2352x1568 · 45° field of view · color fundus photograph:
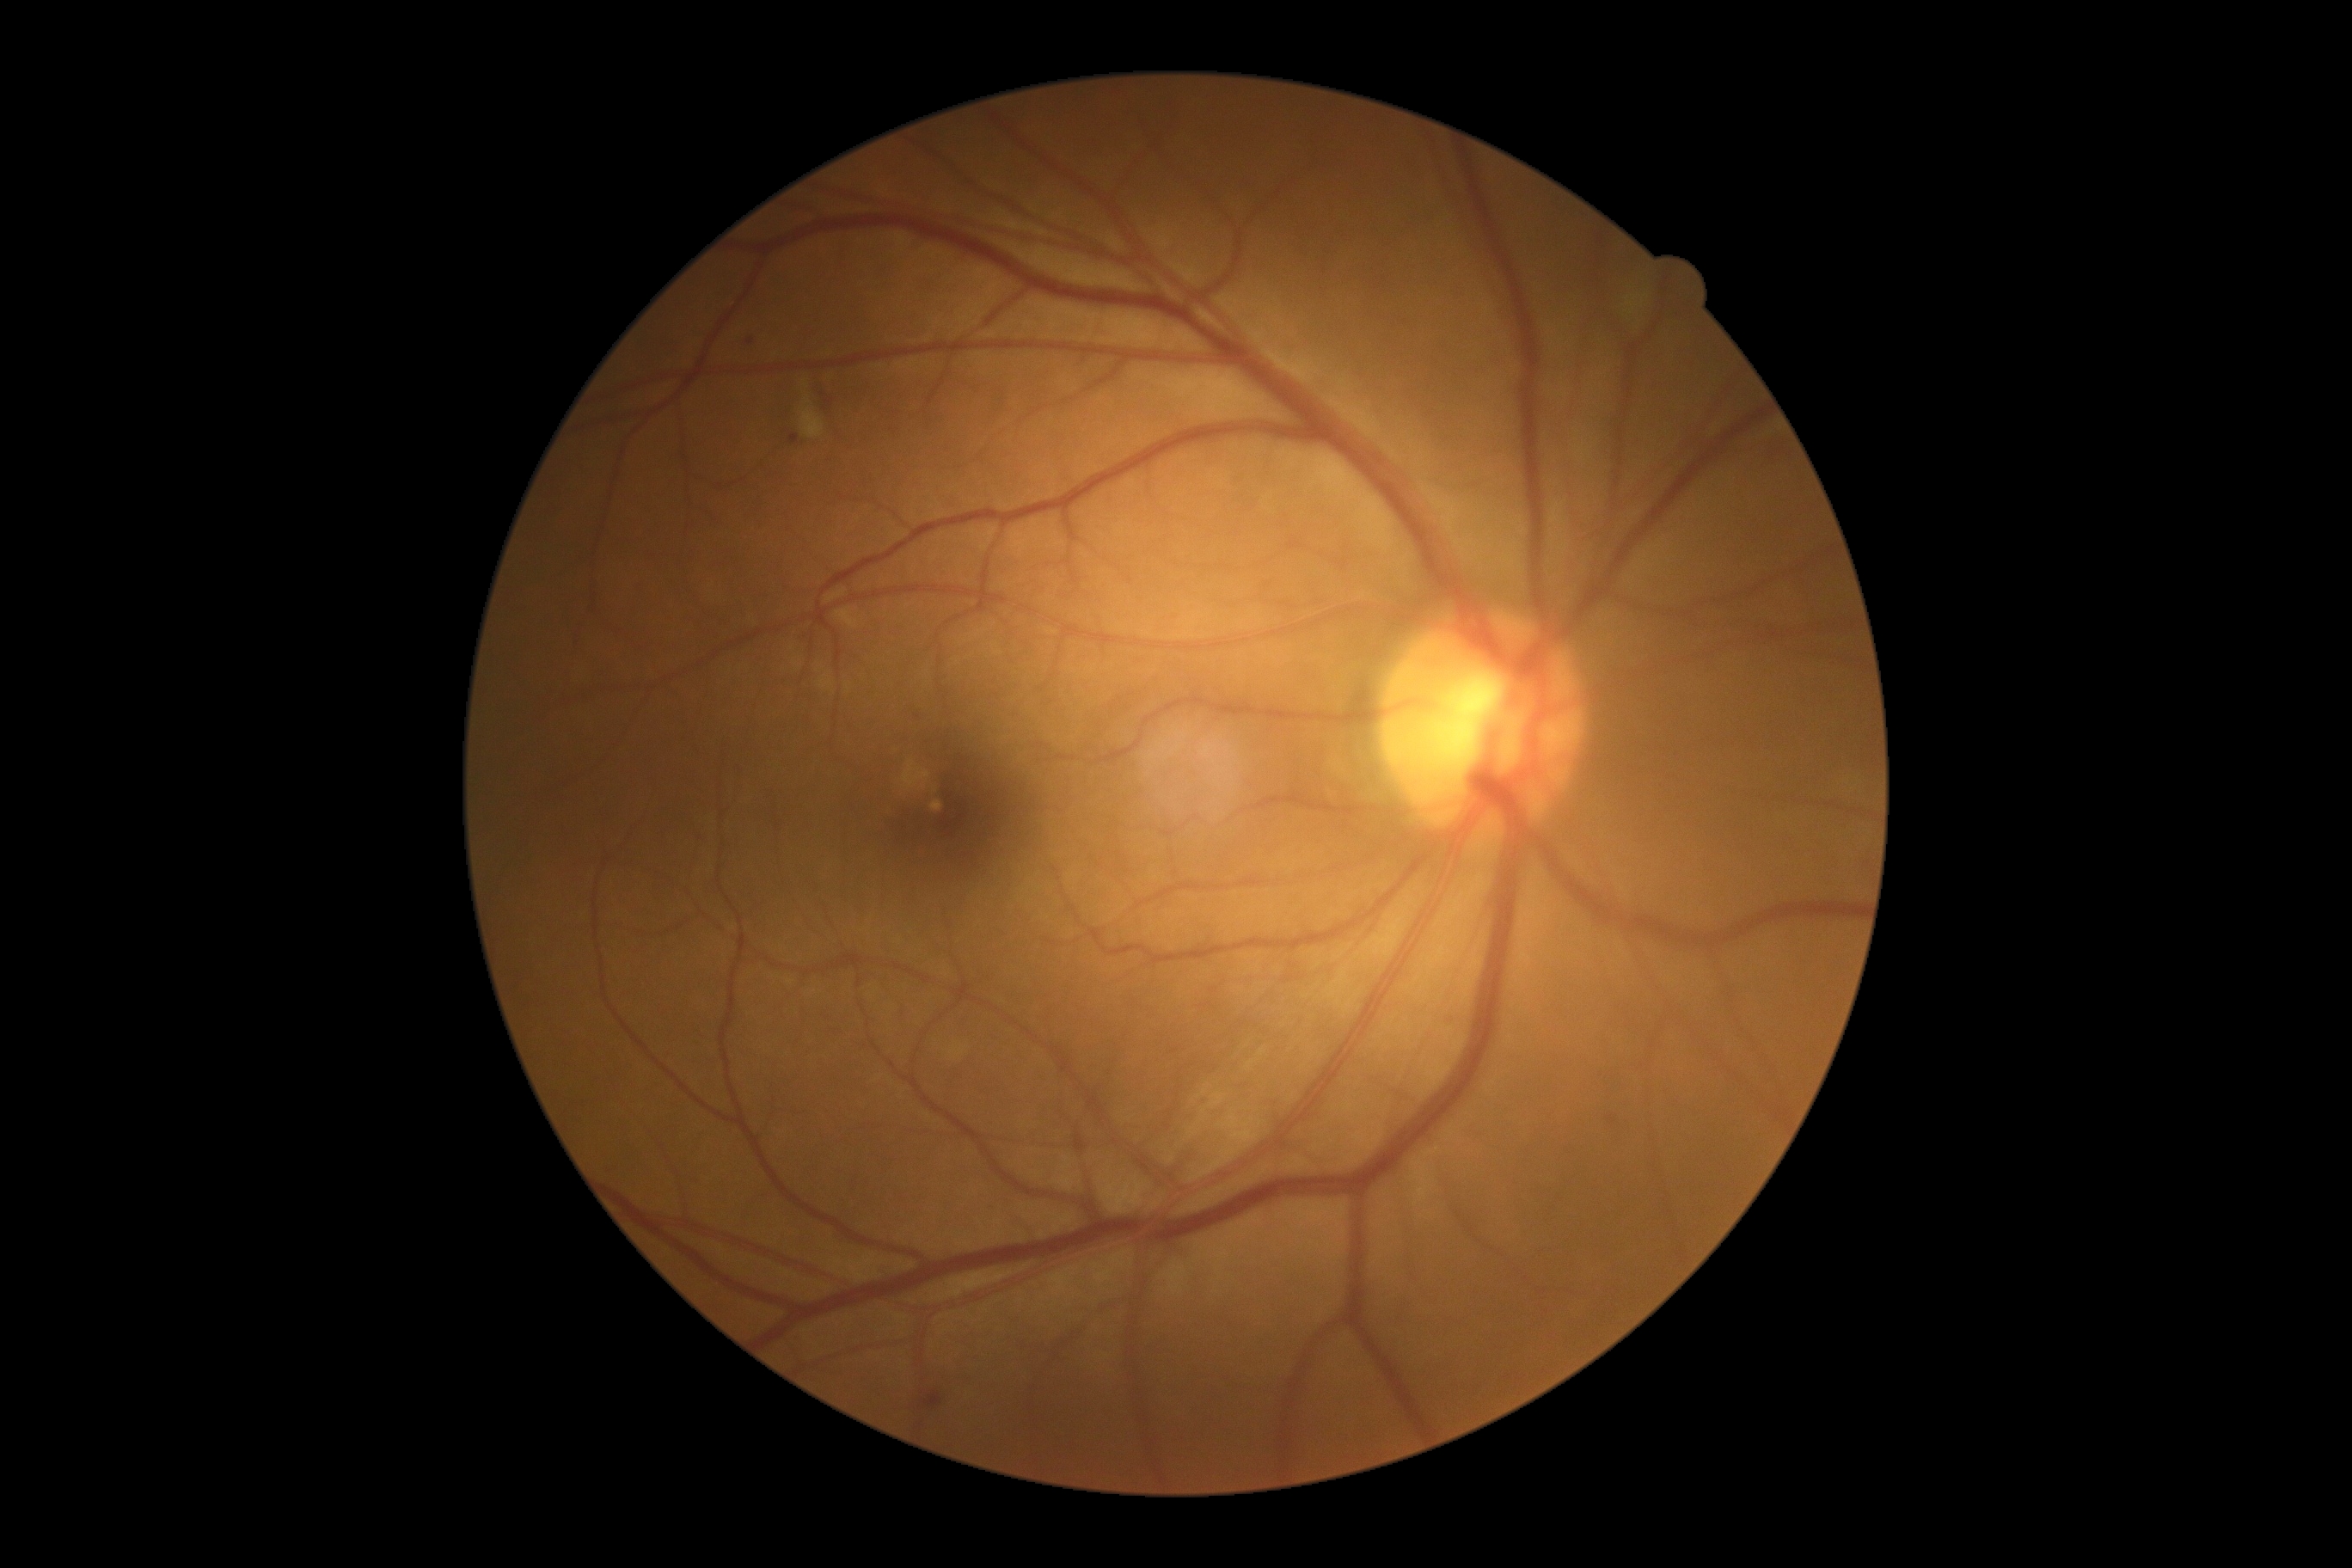

DR is moderate non-proliferative diabetic retinopathy (grade 2).